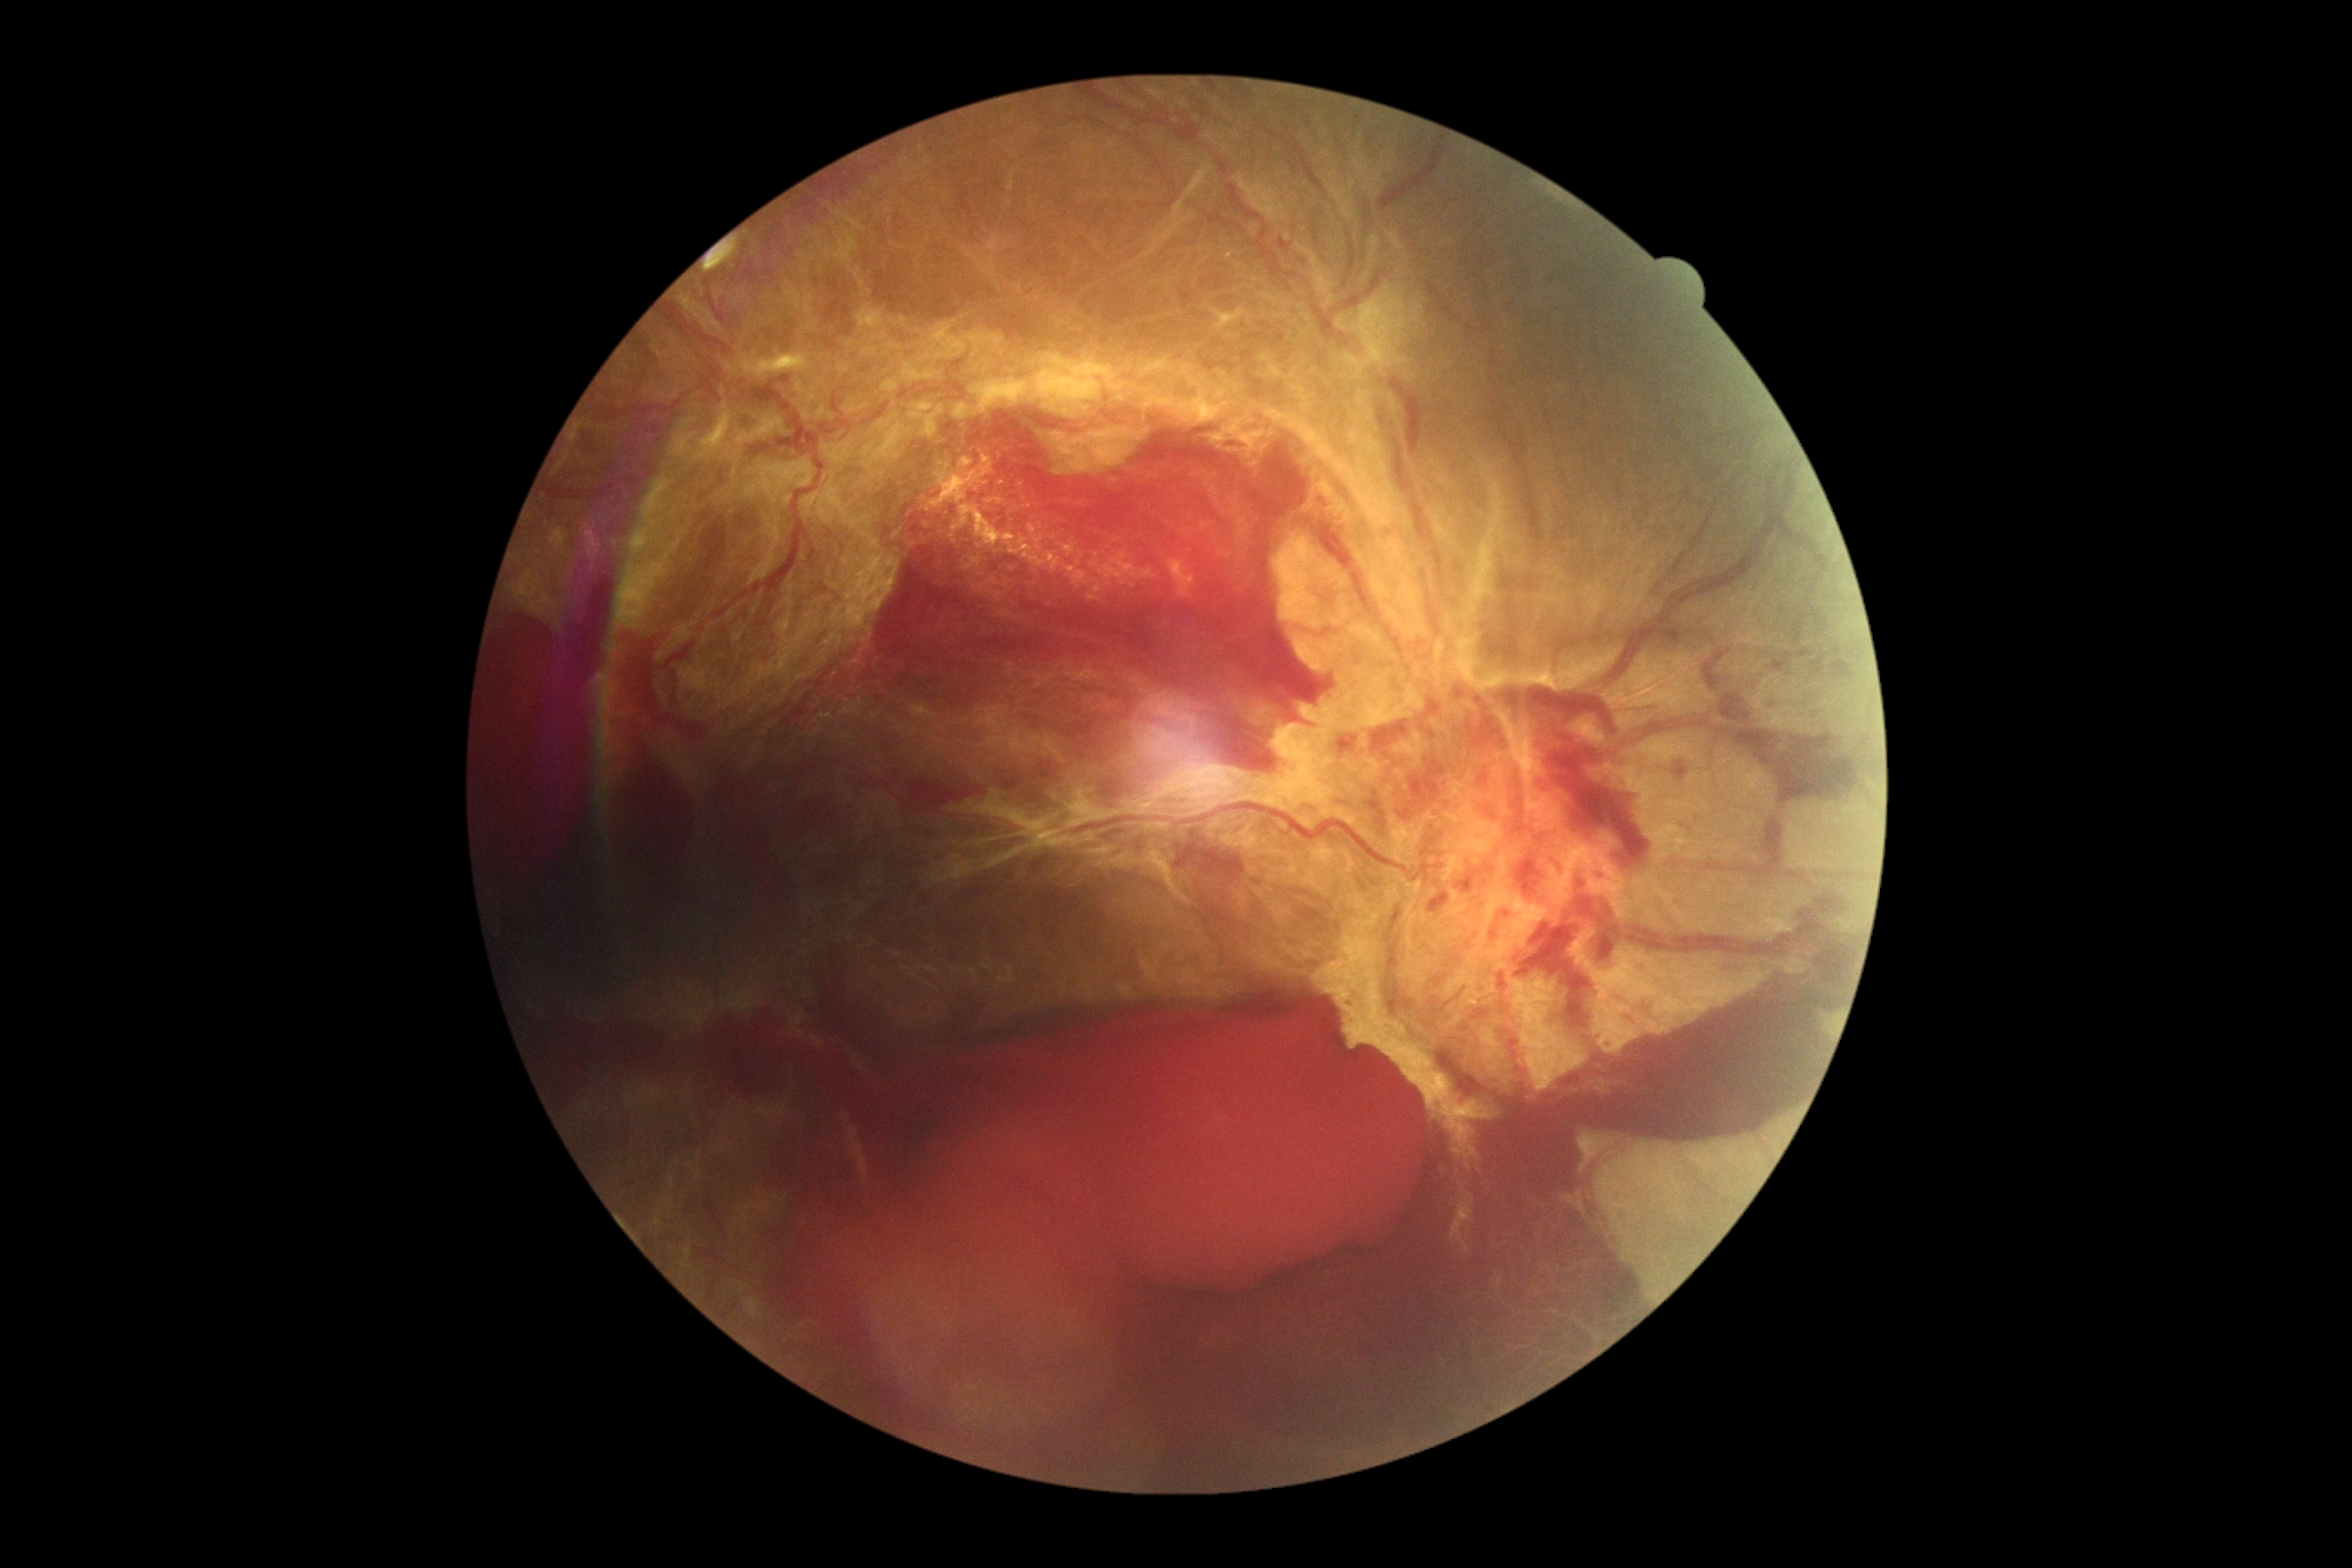

DR grade is PDR (4).